FOV: 45 degrees · without pupil dilation · fundus photo · acquired with a NIDEK AFC-230: 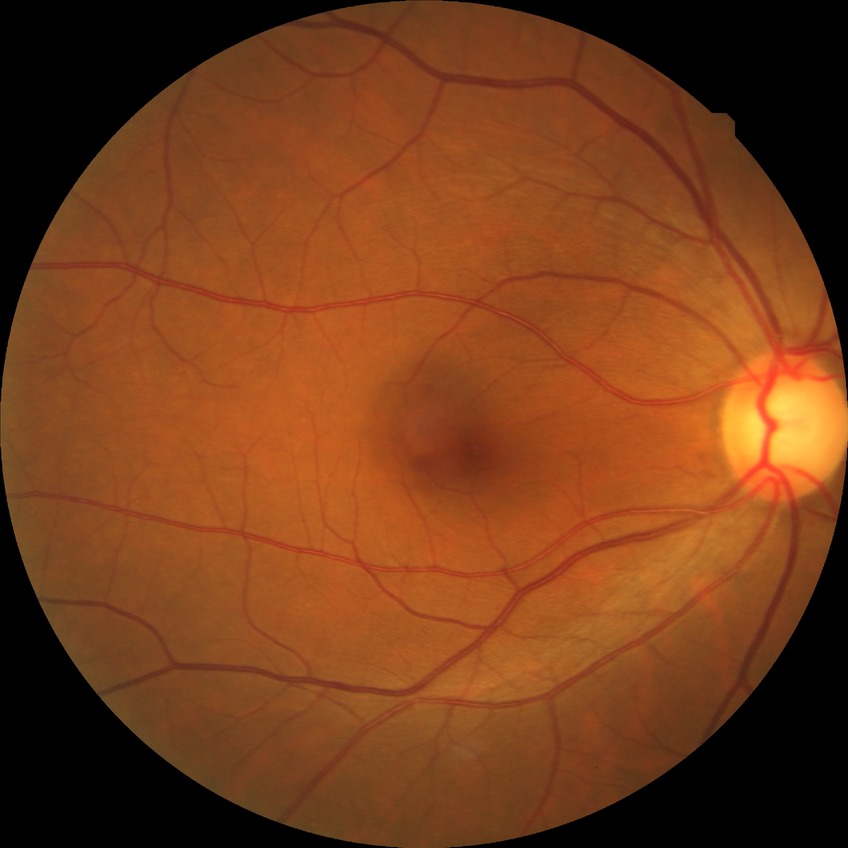

Annotations:
- diabetic retinopathy (DR): NDR (no diabetic retinopathy)